Camera: Nidek AFC-330:
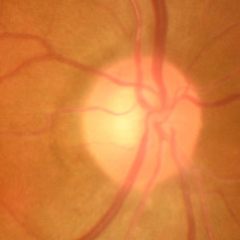

The image shows no evidence of glaucoma.